640 by 480 pixels; infant wide-field fundus photograph
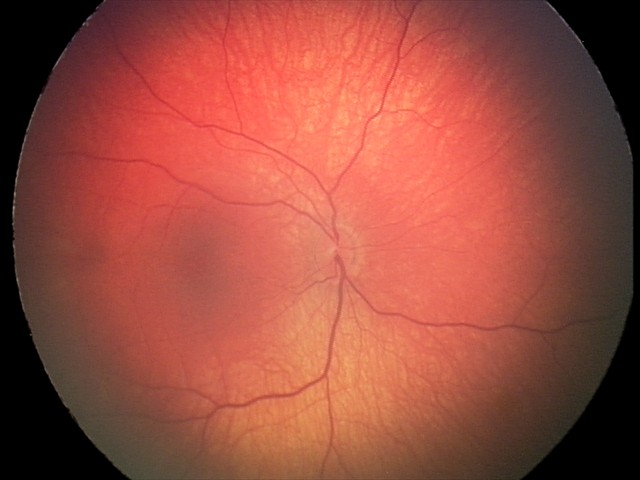

Screening diagnosis: retinal hemorrhages.